848x848 · camera: NIDEK AFC-230 · nonmydriatic fundus photograph · 45-degree field of view
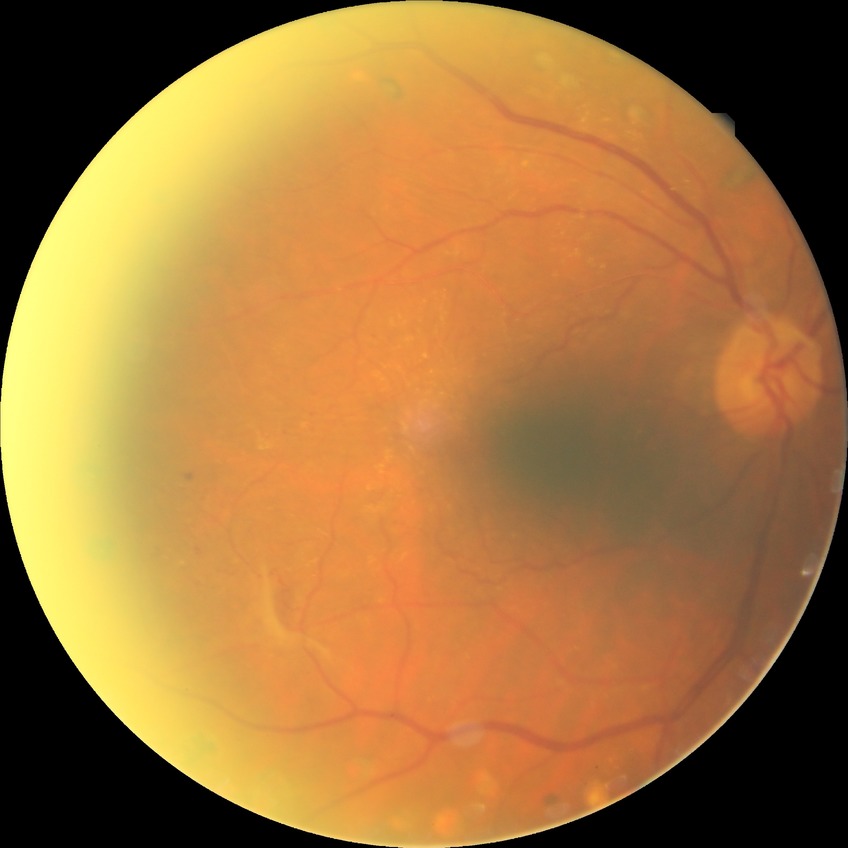
modified Davis classification: proliferative diabetic retinopathy